45 degree fundus photograph, 848x848, DR severity per modified Davis staging.
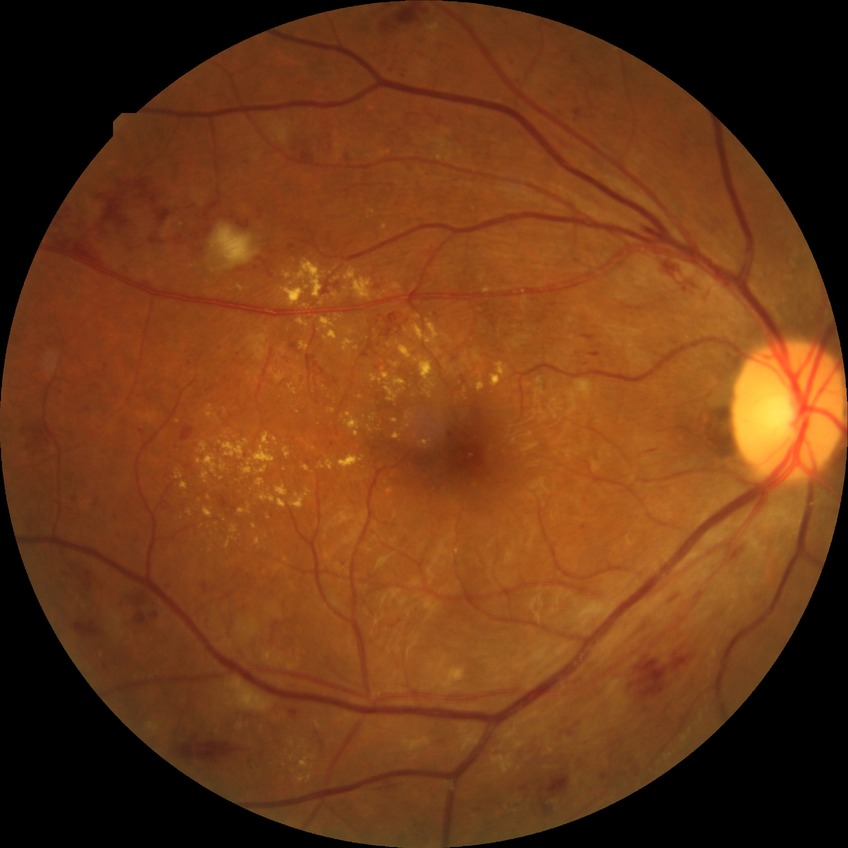 Diabetic retinopathy (DR): pre-proliferative diabetic retinopathy (PPDR).
The retinopathy is classified as non-proliferative diabetic retinopathy.